Fundus photo. 45° field of view. Modified Davis classification — 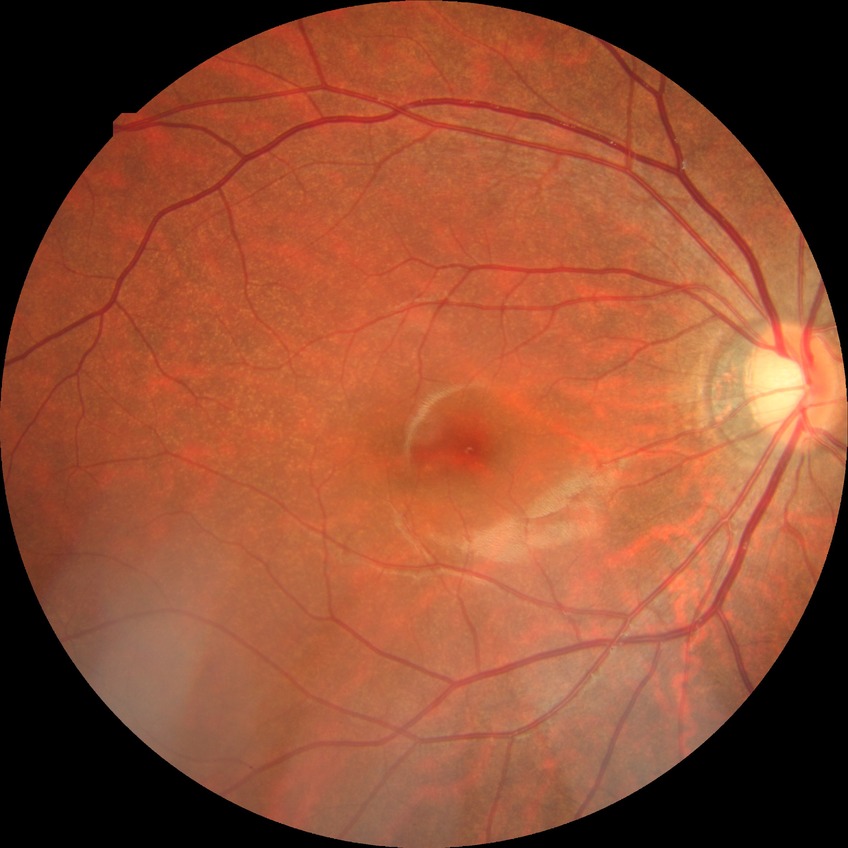

Diabetic retinopathy (DR) is no diabetic retinopathy (NDR).